240x240
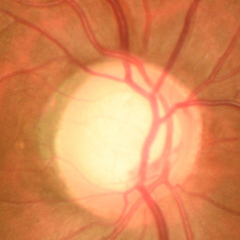 Color fundus photograph showing early glaucomatous optic neuropathy.